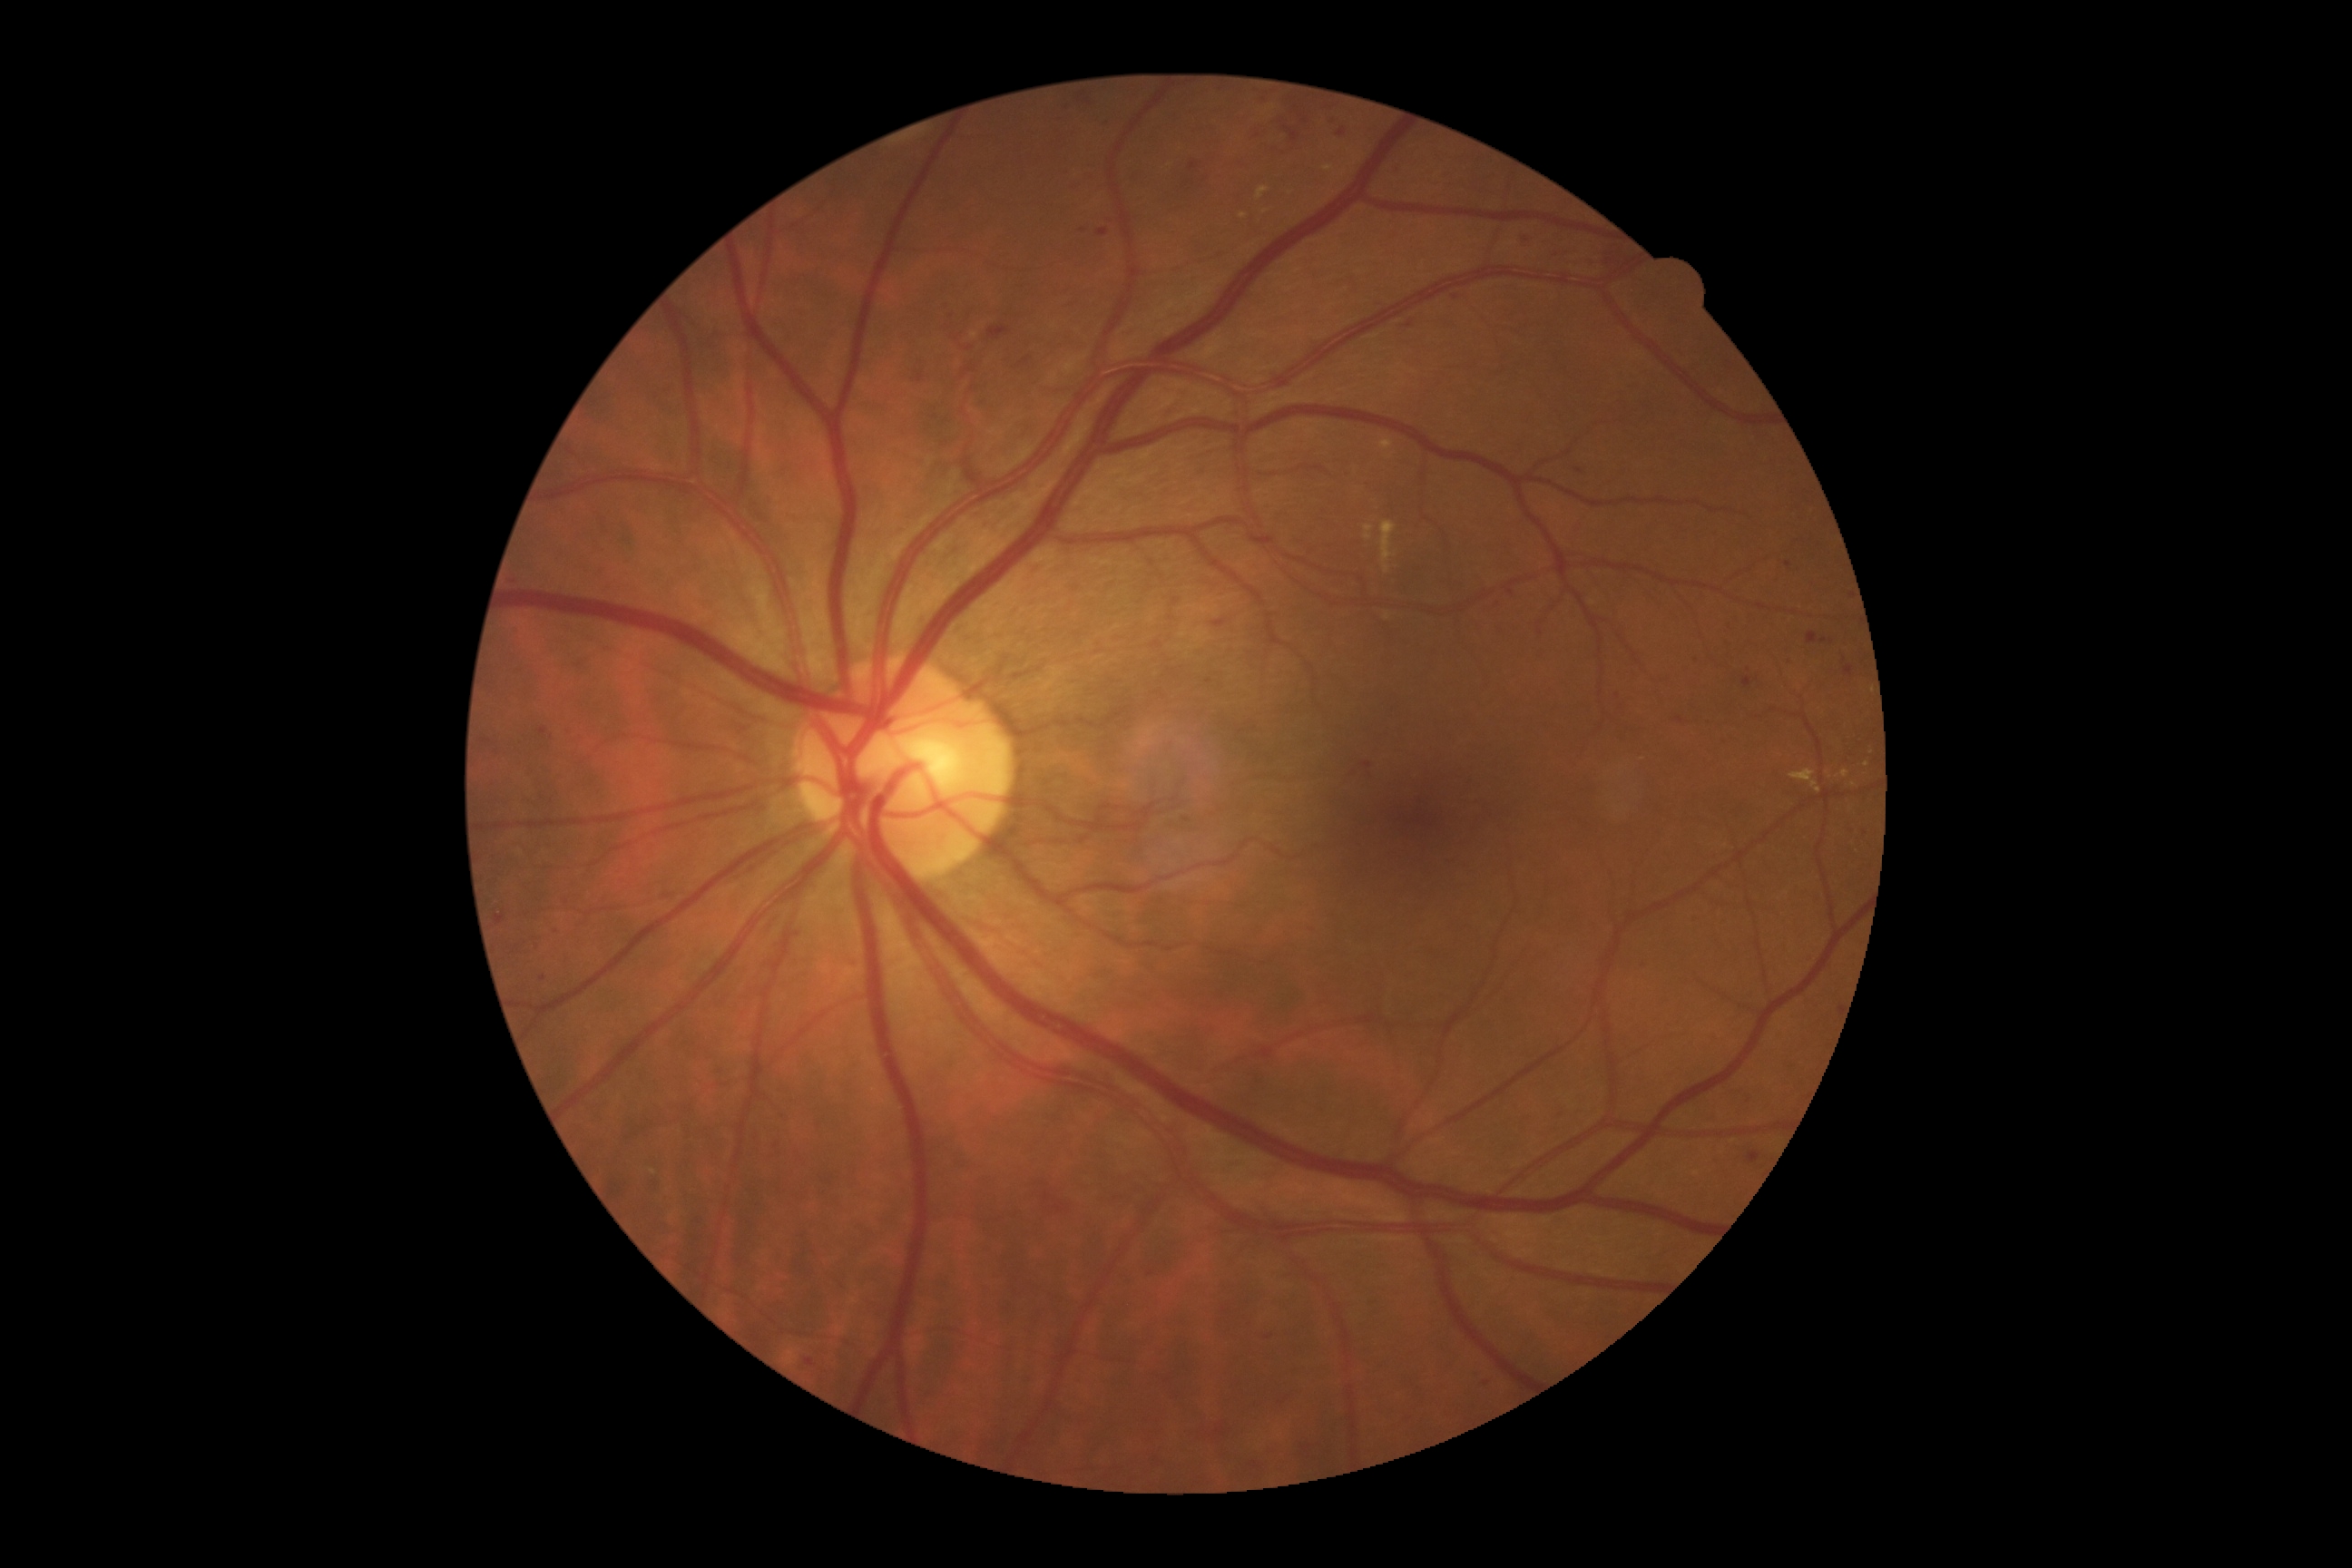 DR severity is moderate NPDR (grade 2) — more than just microaneurysms but less than severe NPDR.
HEs include lesions at 767:1137:783:1161; 718:1063:730:1075; 814:1119:823:1135; 1186:161:1202:175; 1171:598:1181:605; 1743:678:1752:689; 482:740:491:743; 1407:322:1415:329; 1293:1442:1317:1456; 1807:632:1818:645; 1389:166:1411:179; 495:916:505:925; 750:495:778:525; 845:959:861:972; 1612:691:1622:700; 950:1141:985:1173.
Small HEs near pt(1083, 231); pt(1021, 366).